848 by 848 pixels. 45° field of view. NIDEK AFC-230 fundus camera:
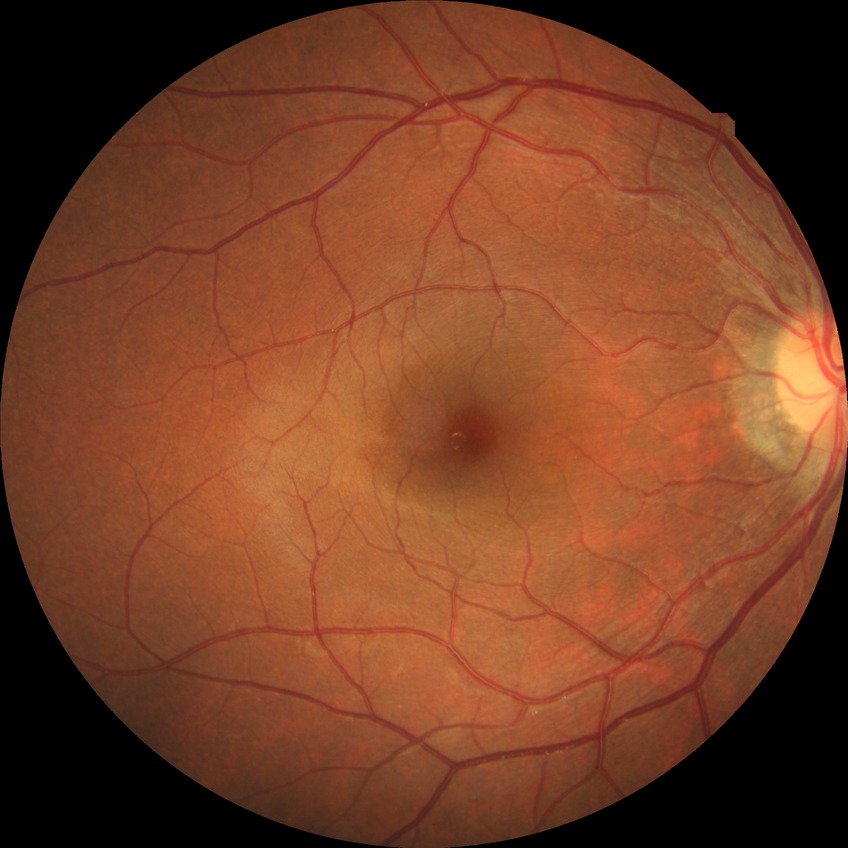

{"dr_impression": "no apparent DR", "davis_grade": "NDR"}